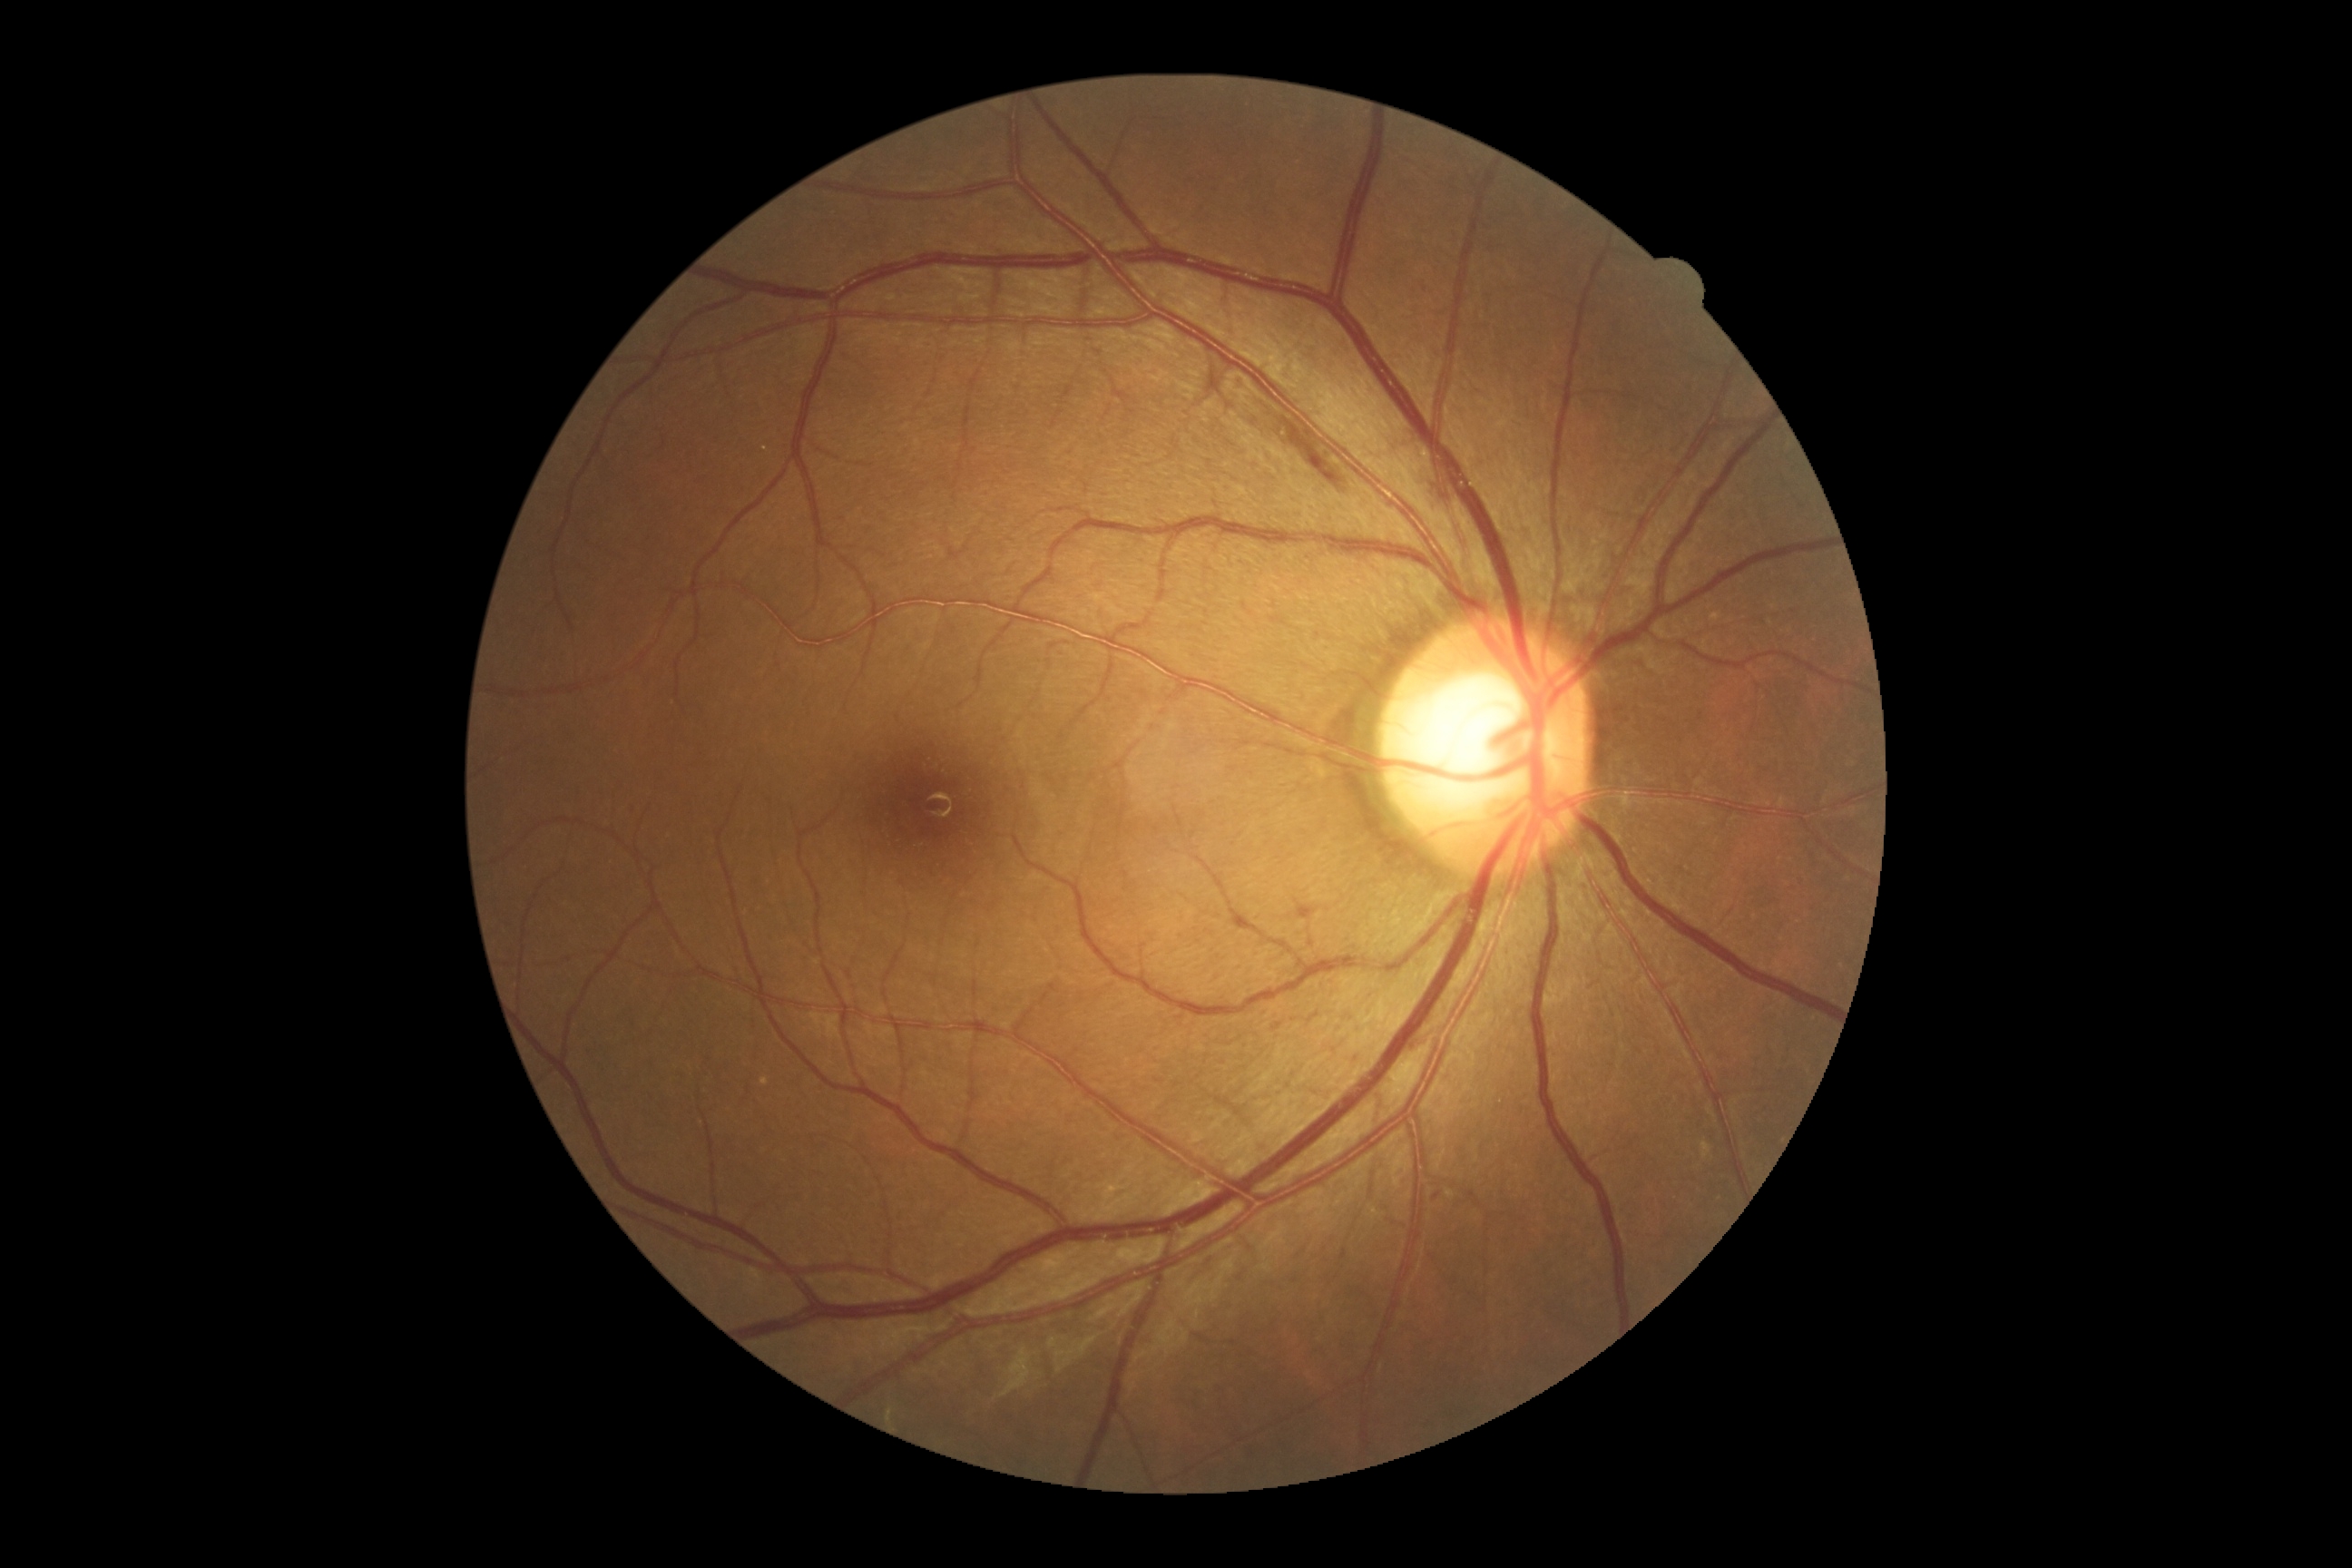 DR: grade 2.